640 x 480 pixels. Pediatric wide-field fundus photograph
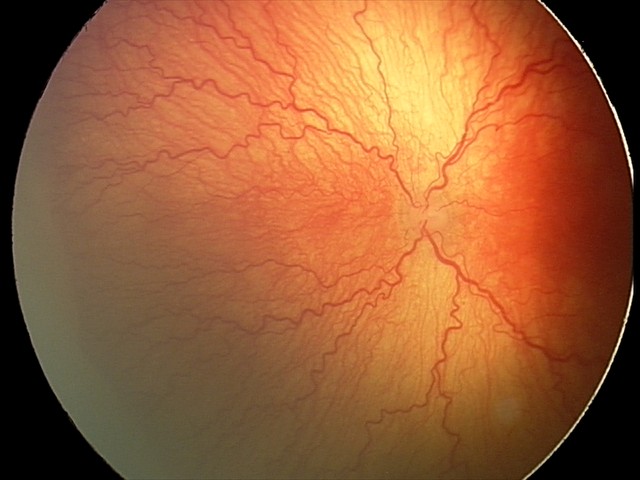
Screening series with aggressive ROP (A-ROP). Plus disease present.